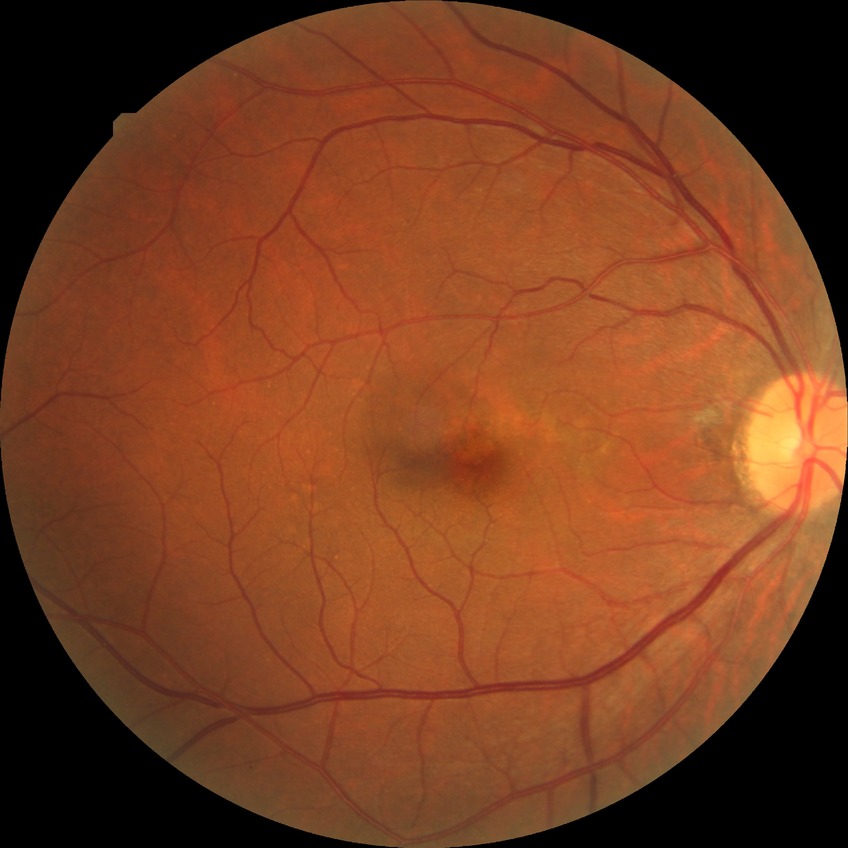 Davis grade: NDR, DR impression: no DR findings.